Posterior pole photograph, 45-degree field of view: 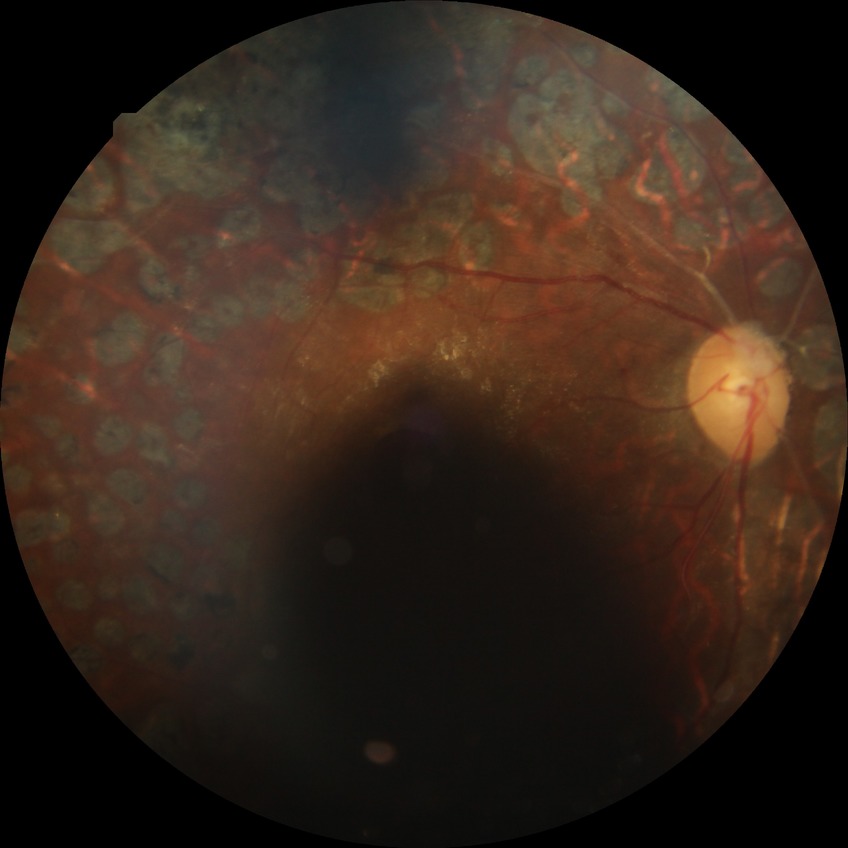

Diabetic retinopathy (DR) is PDR (proliferative diabetic retinopathy).